1659 by 2212 pixels, retinal fundus photograph.
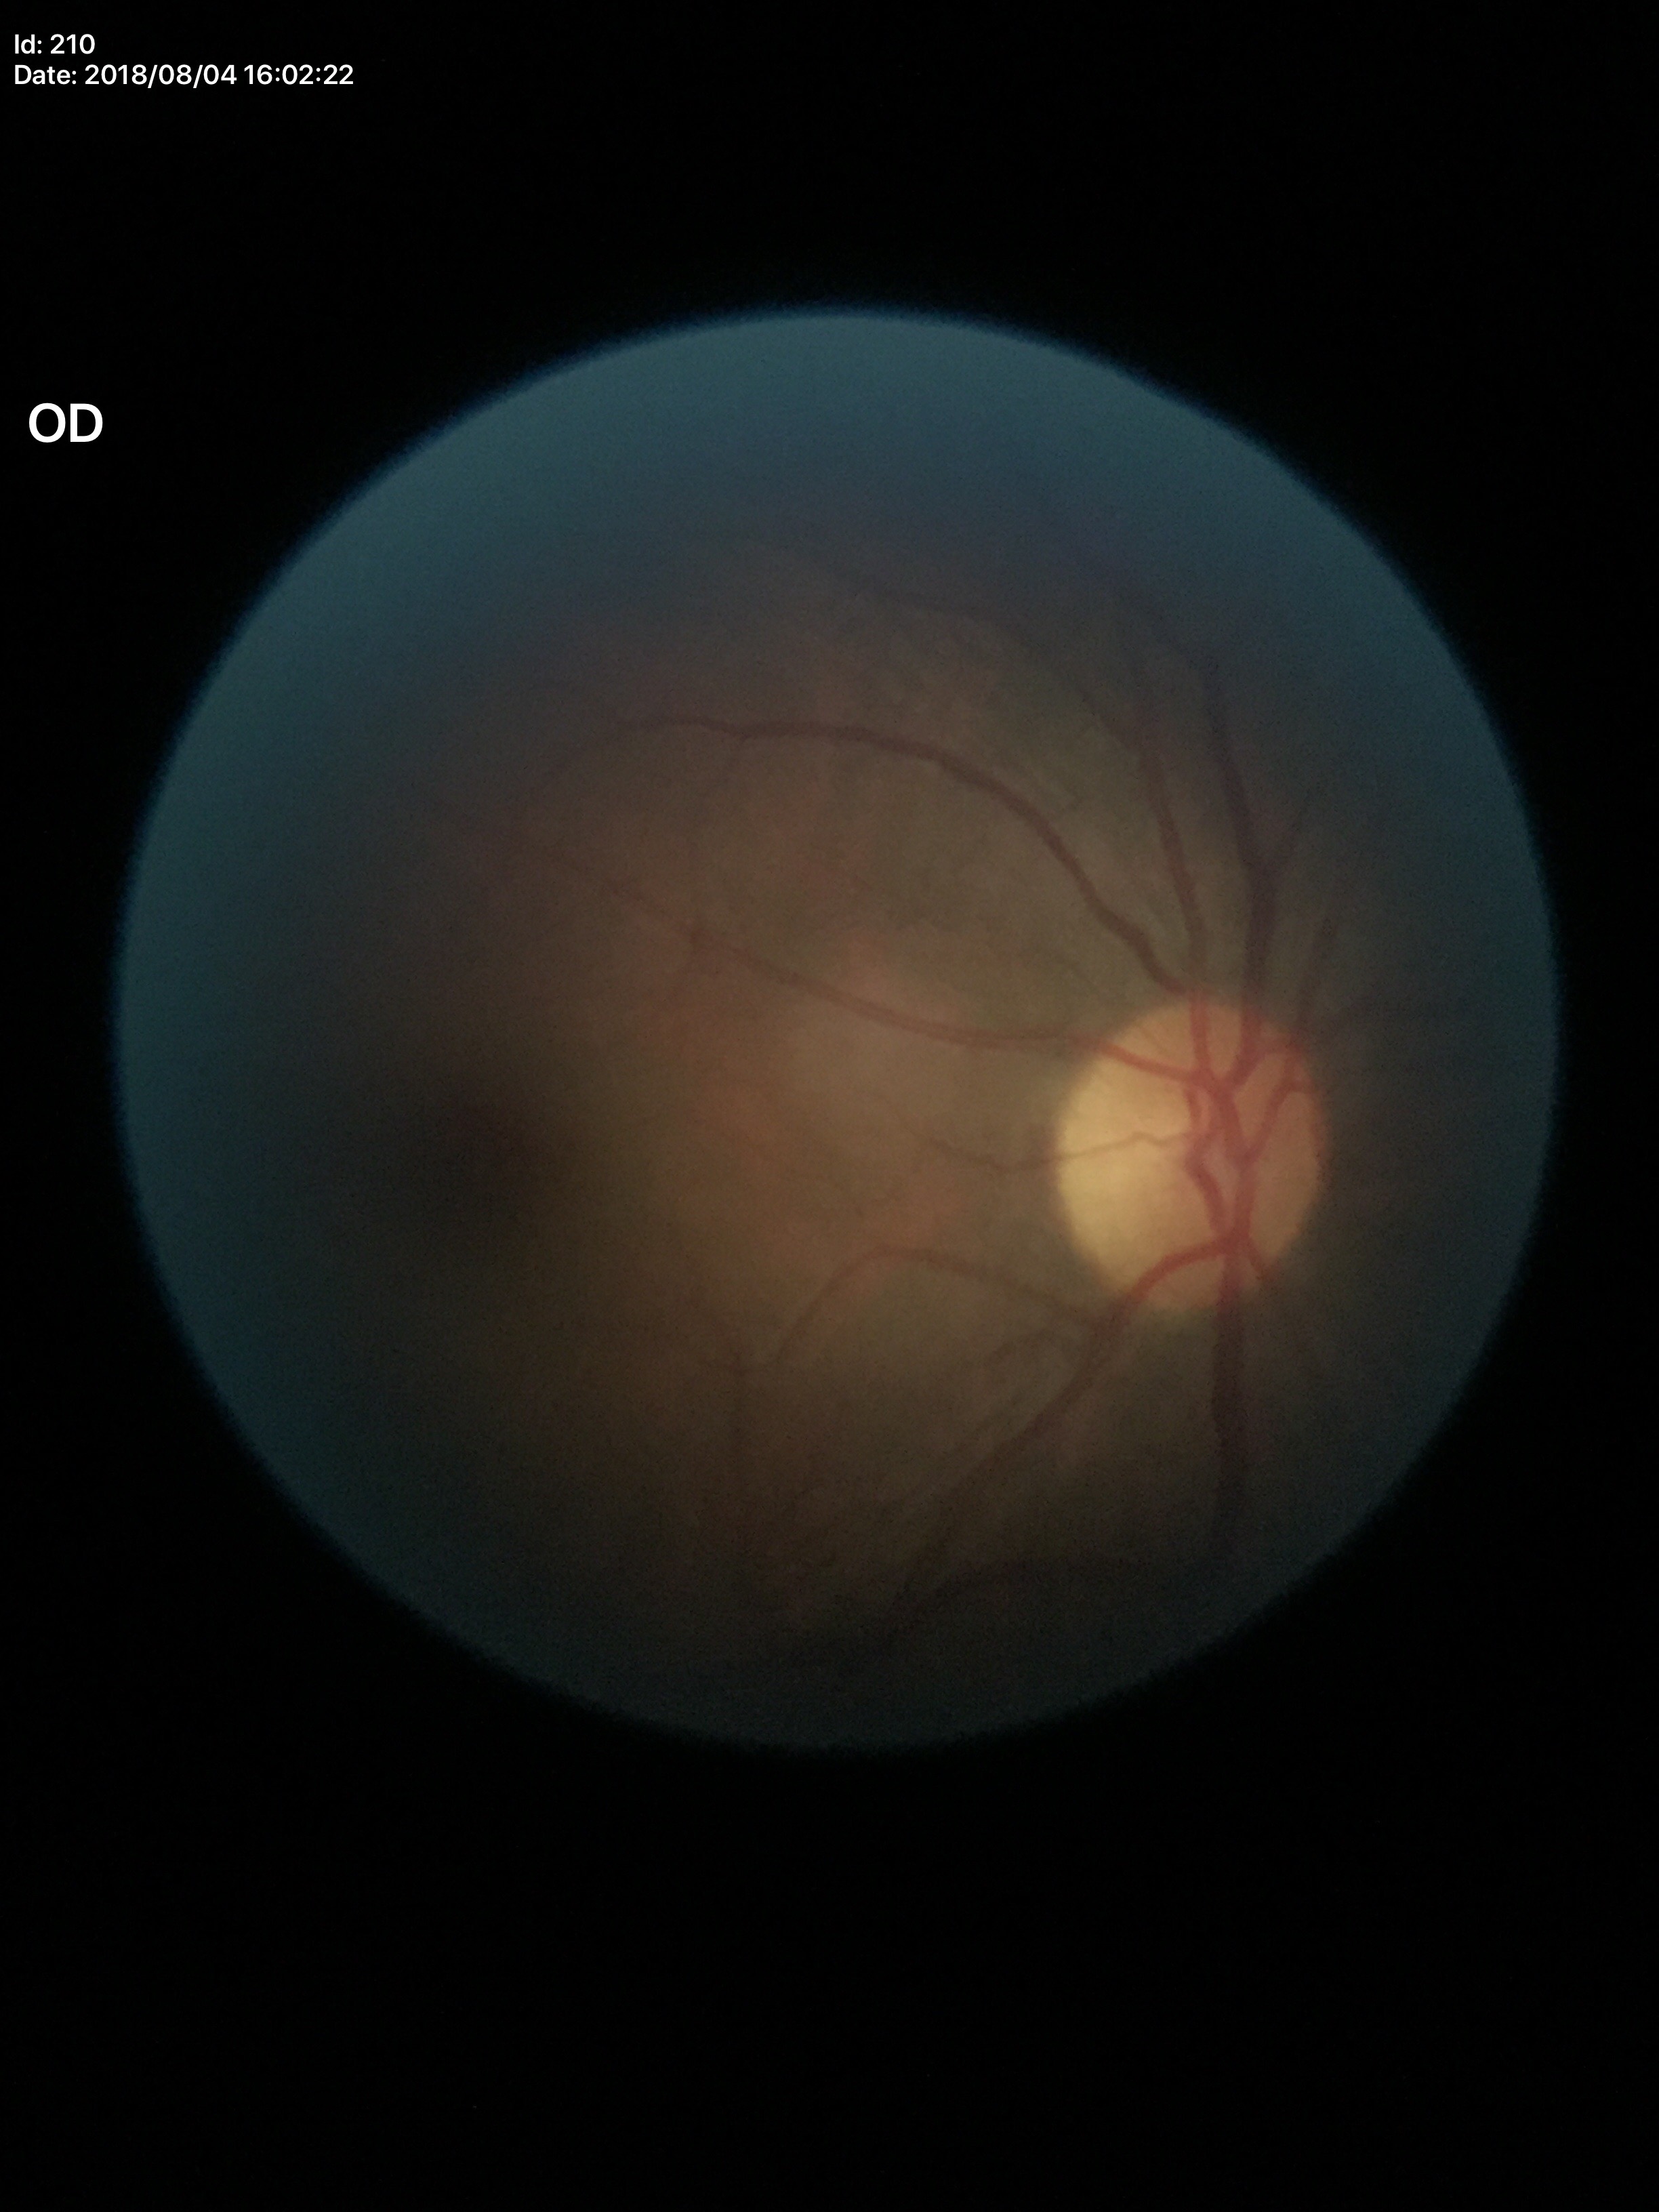

Horizontal C/D ratio of 0.50.
Vertical CDR is 0.50.
Not suspicious for glaucoma (unanimous normal call).